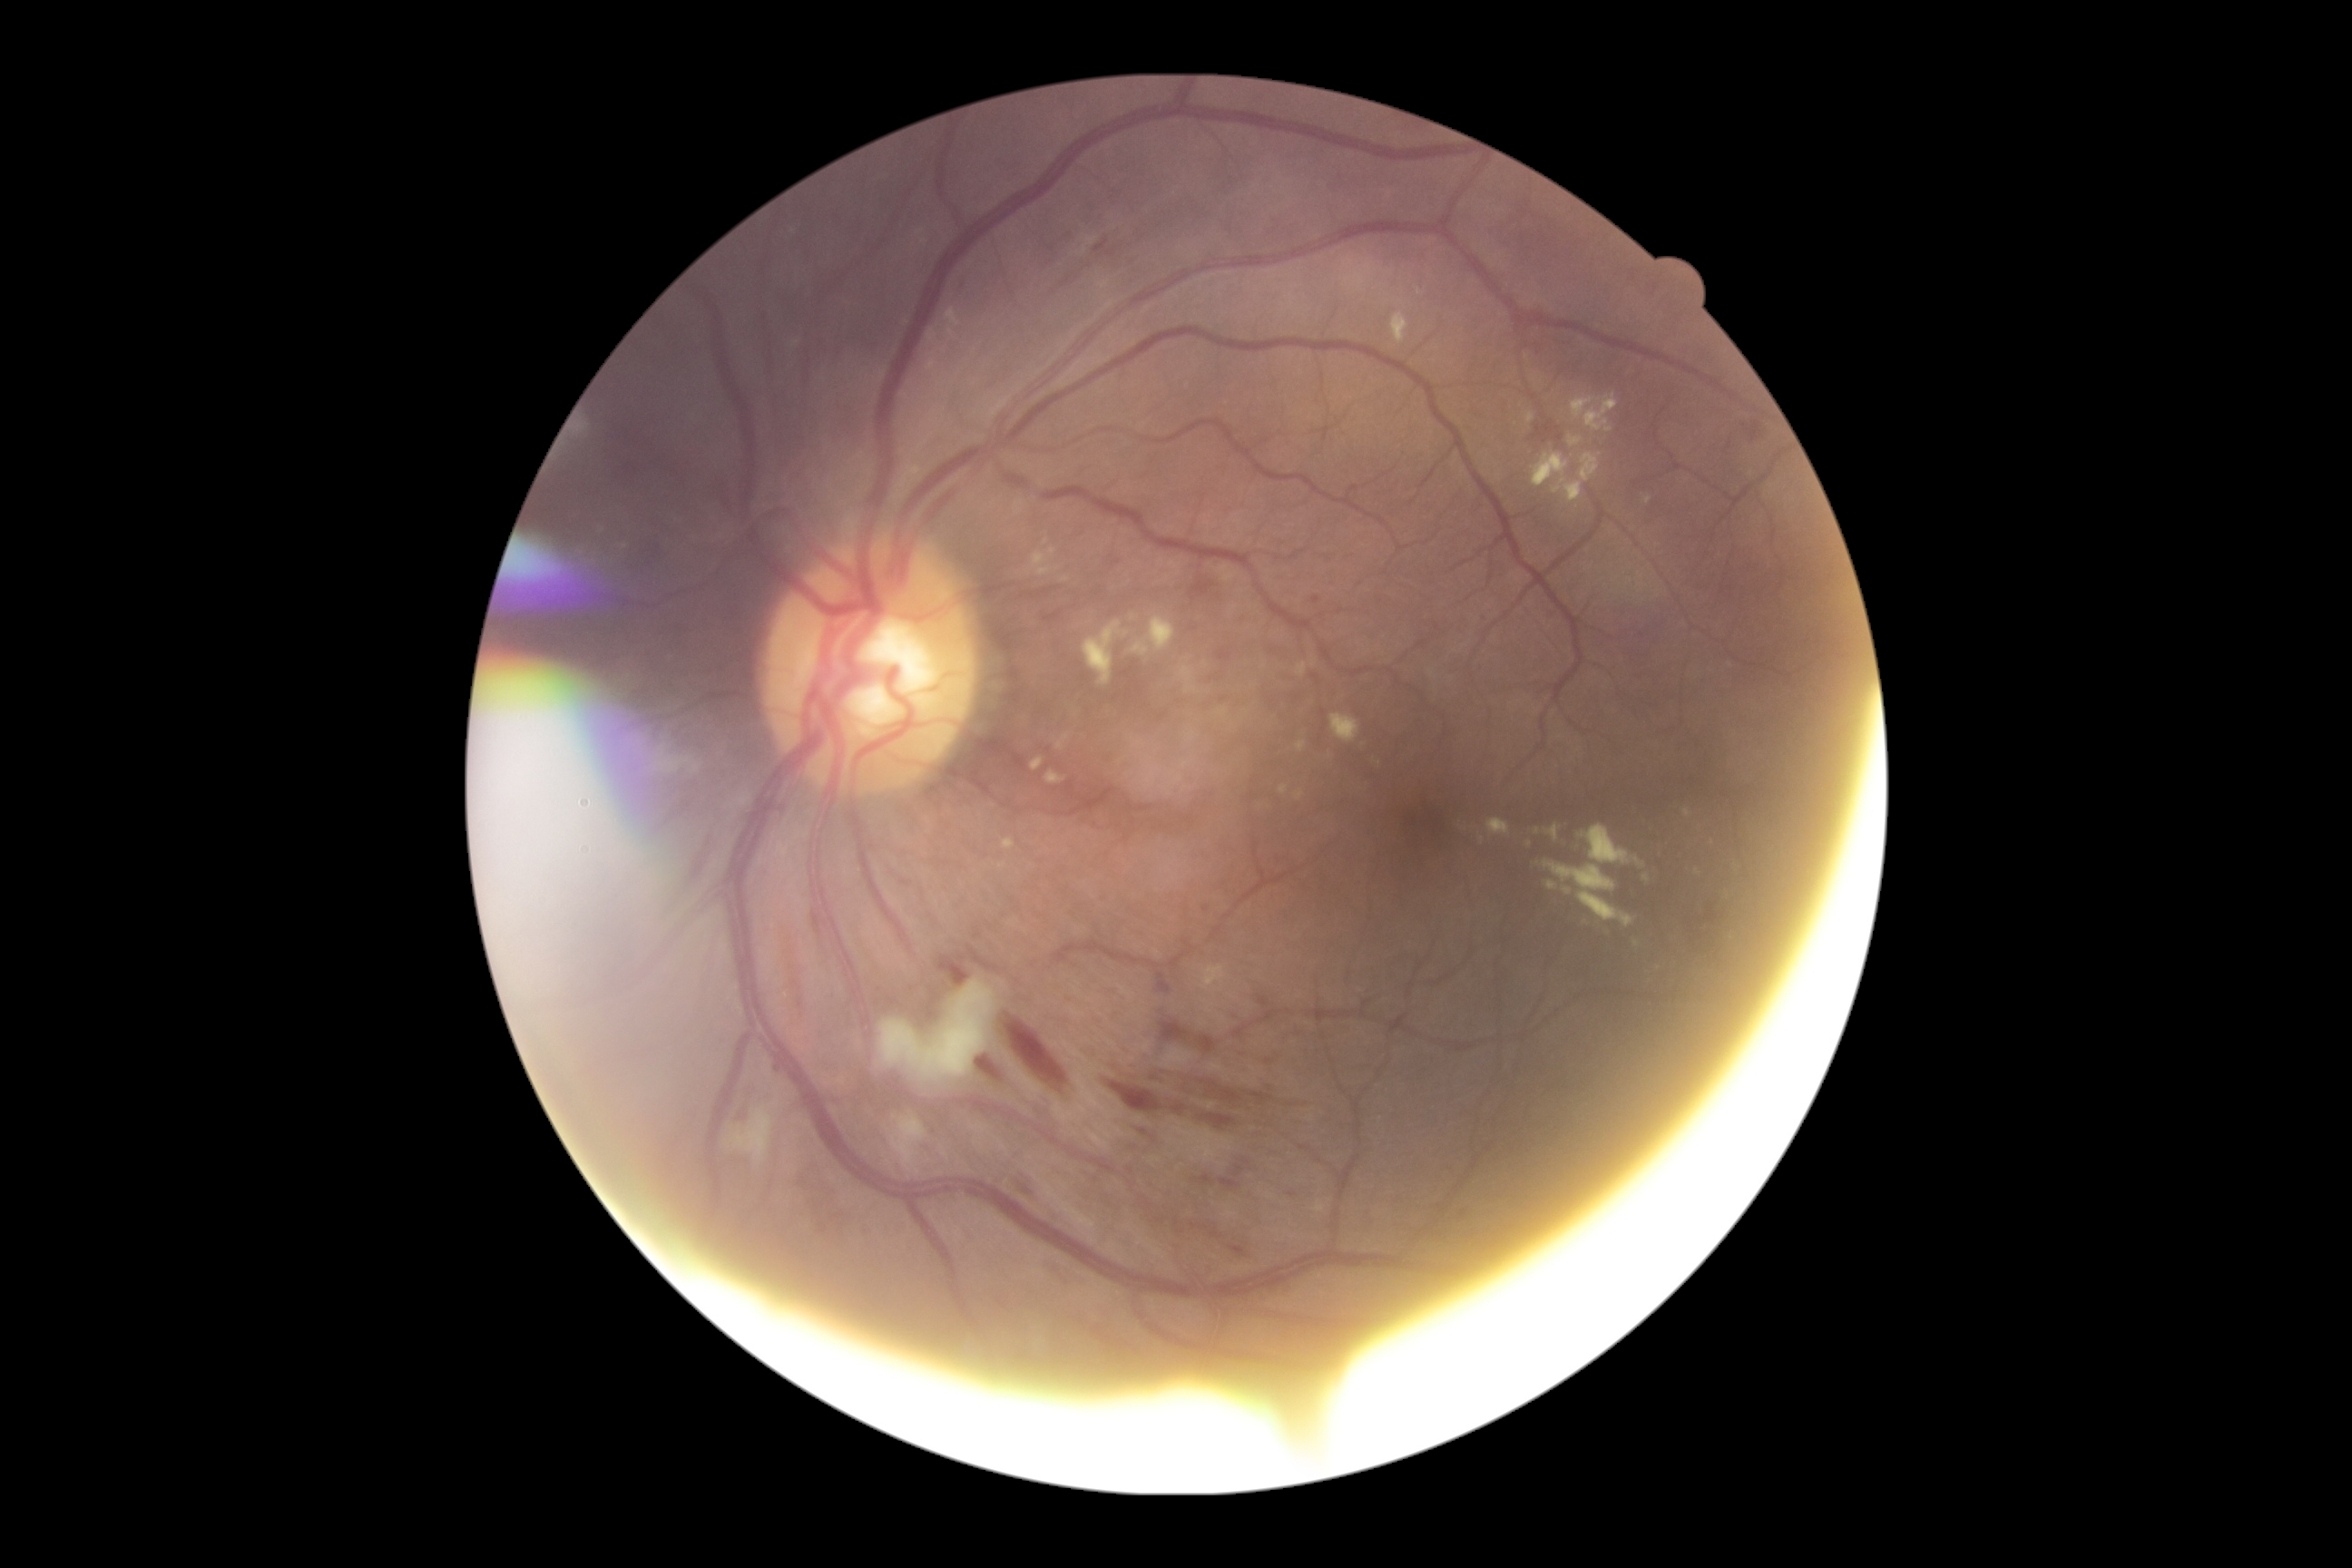
DR: grade 2 (moderate NPDR).